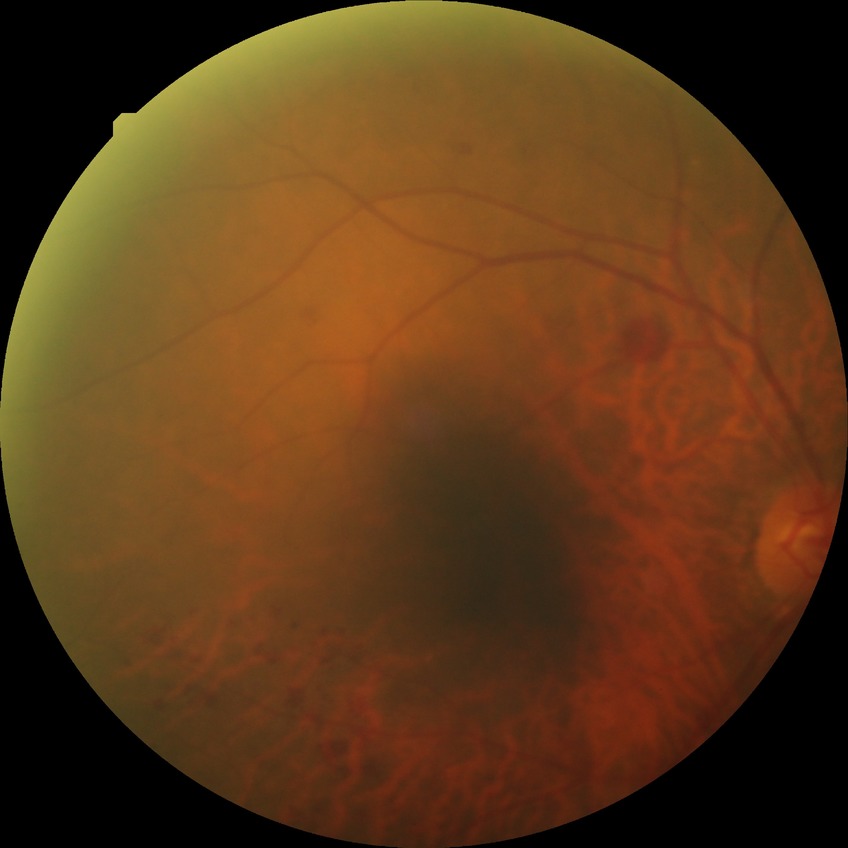 Diabetic retinopathy (DR): SDR (simple diabetic retinopathy).